DR severity per modified Davis staging. 848x848px — 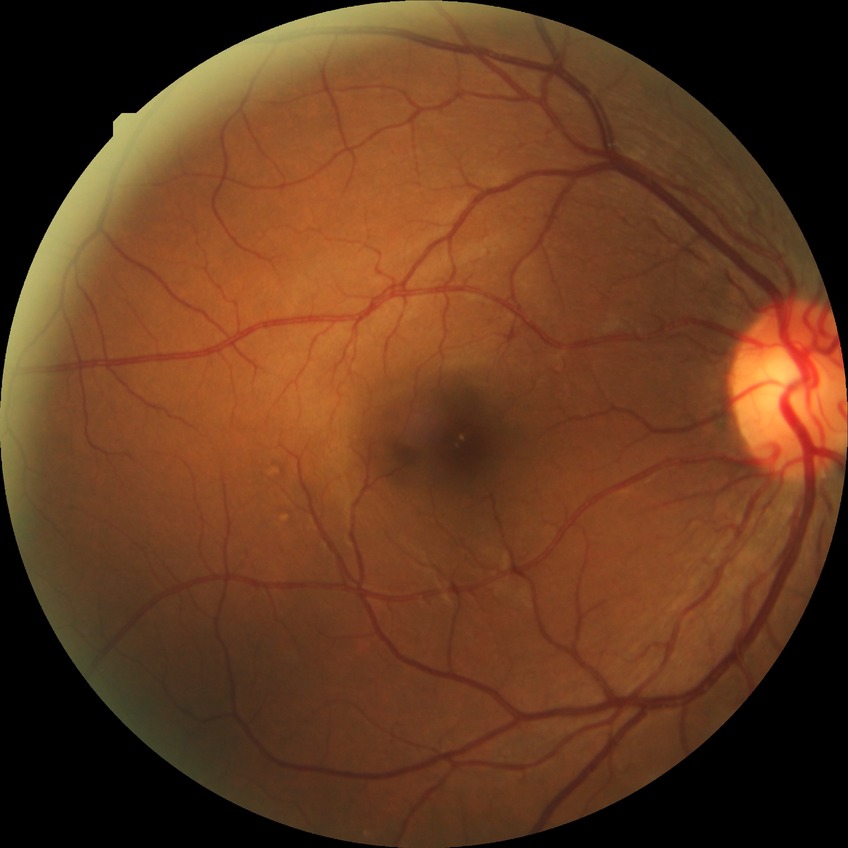 Diabetic retinopathy (DR): SDR (simple diabetic retinopathy).